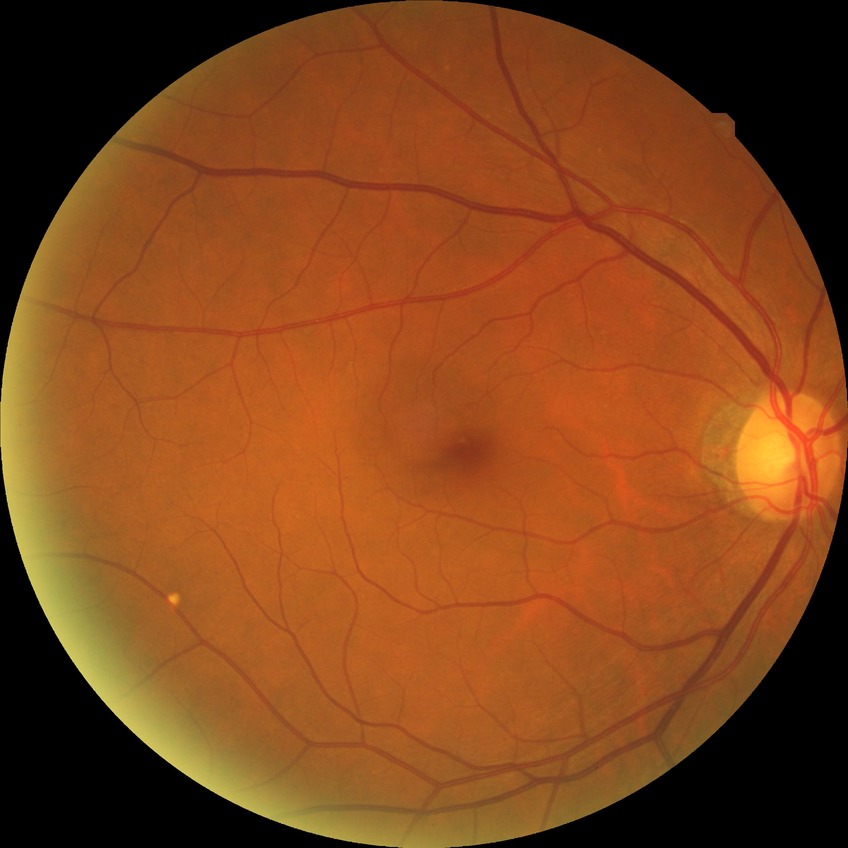
Diabetic retinopathy severity: no diabetic retinopathy.